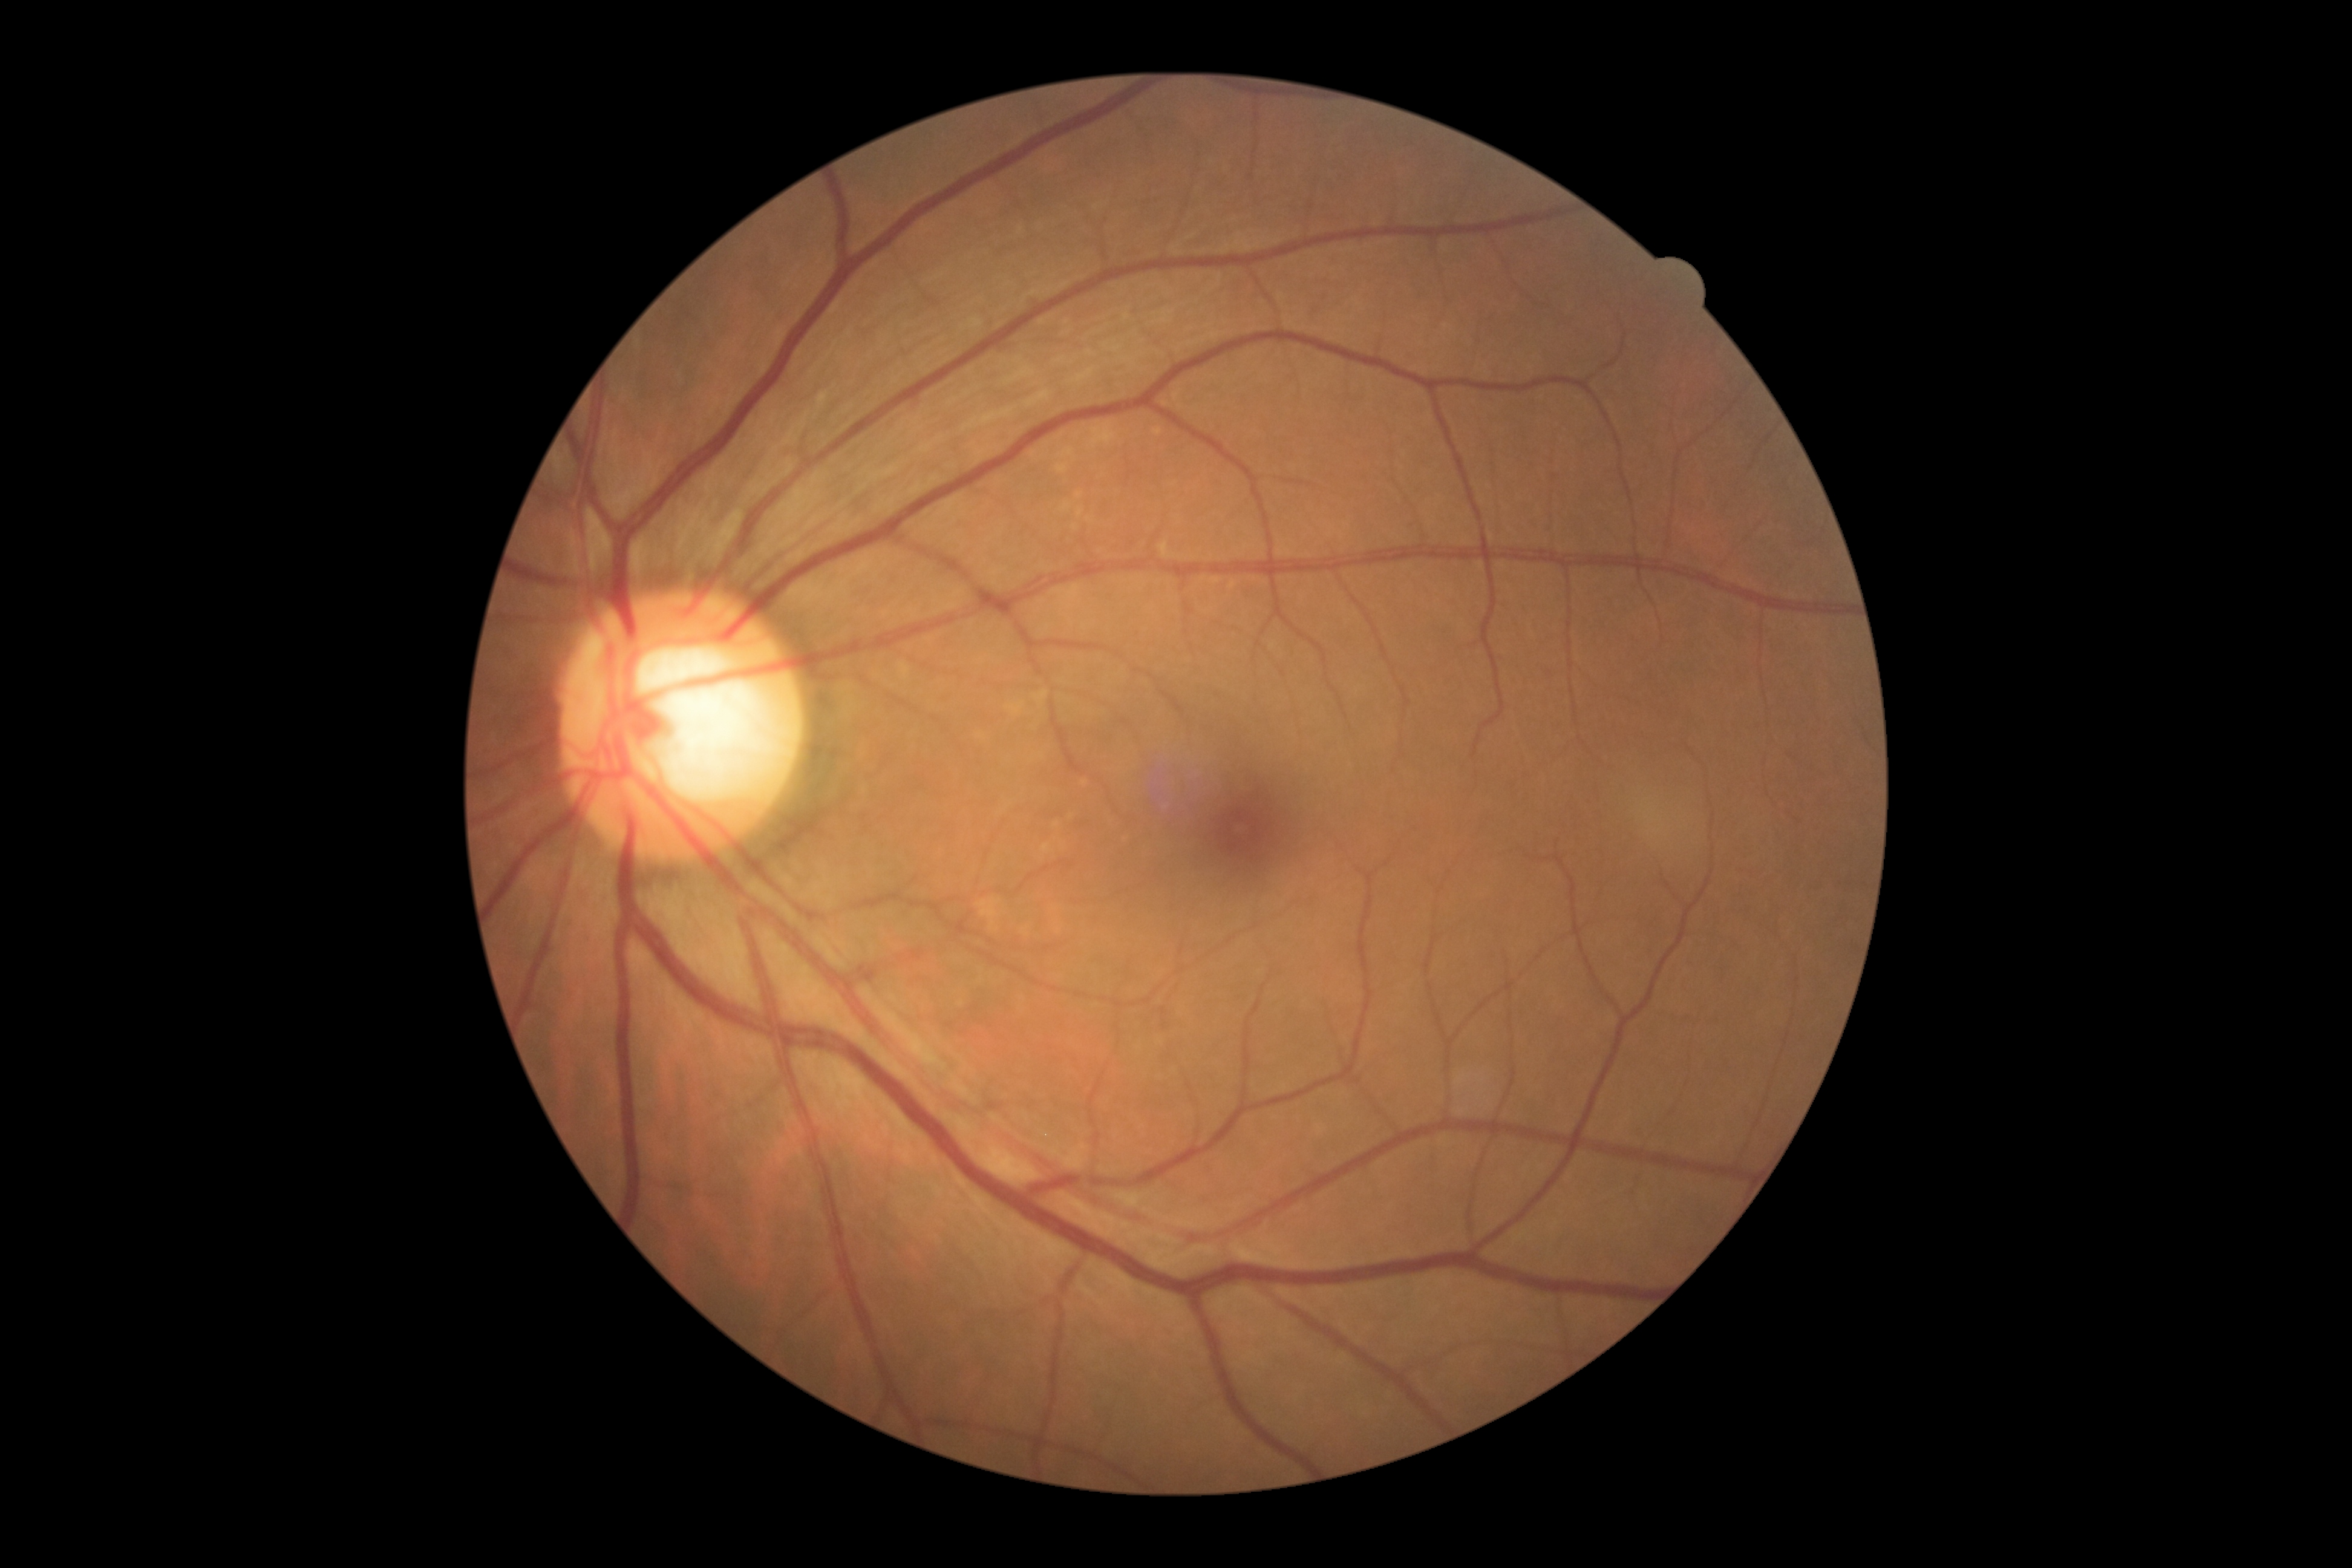 Retinopathy is 0.